Without pupil dilation; posterior pole color fundus photograph
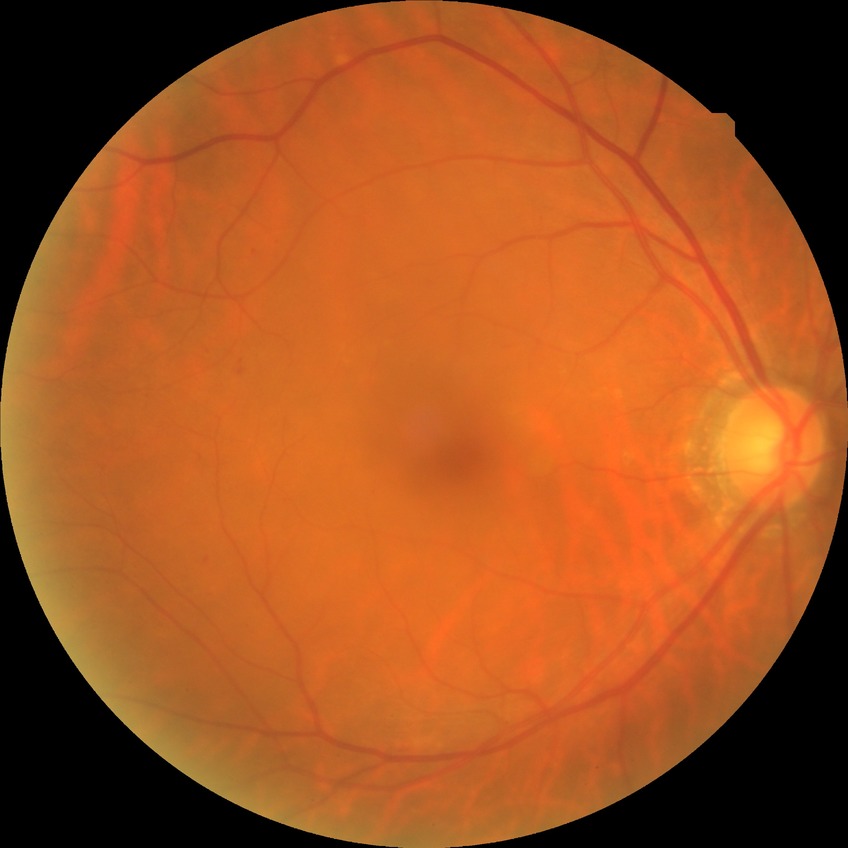

diabetic retinopathy (DR) = NDR (no diabetic retinopathy).